Ultra-widefield fundus mosaic.
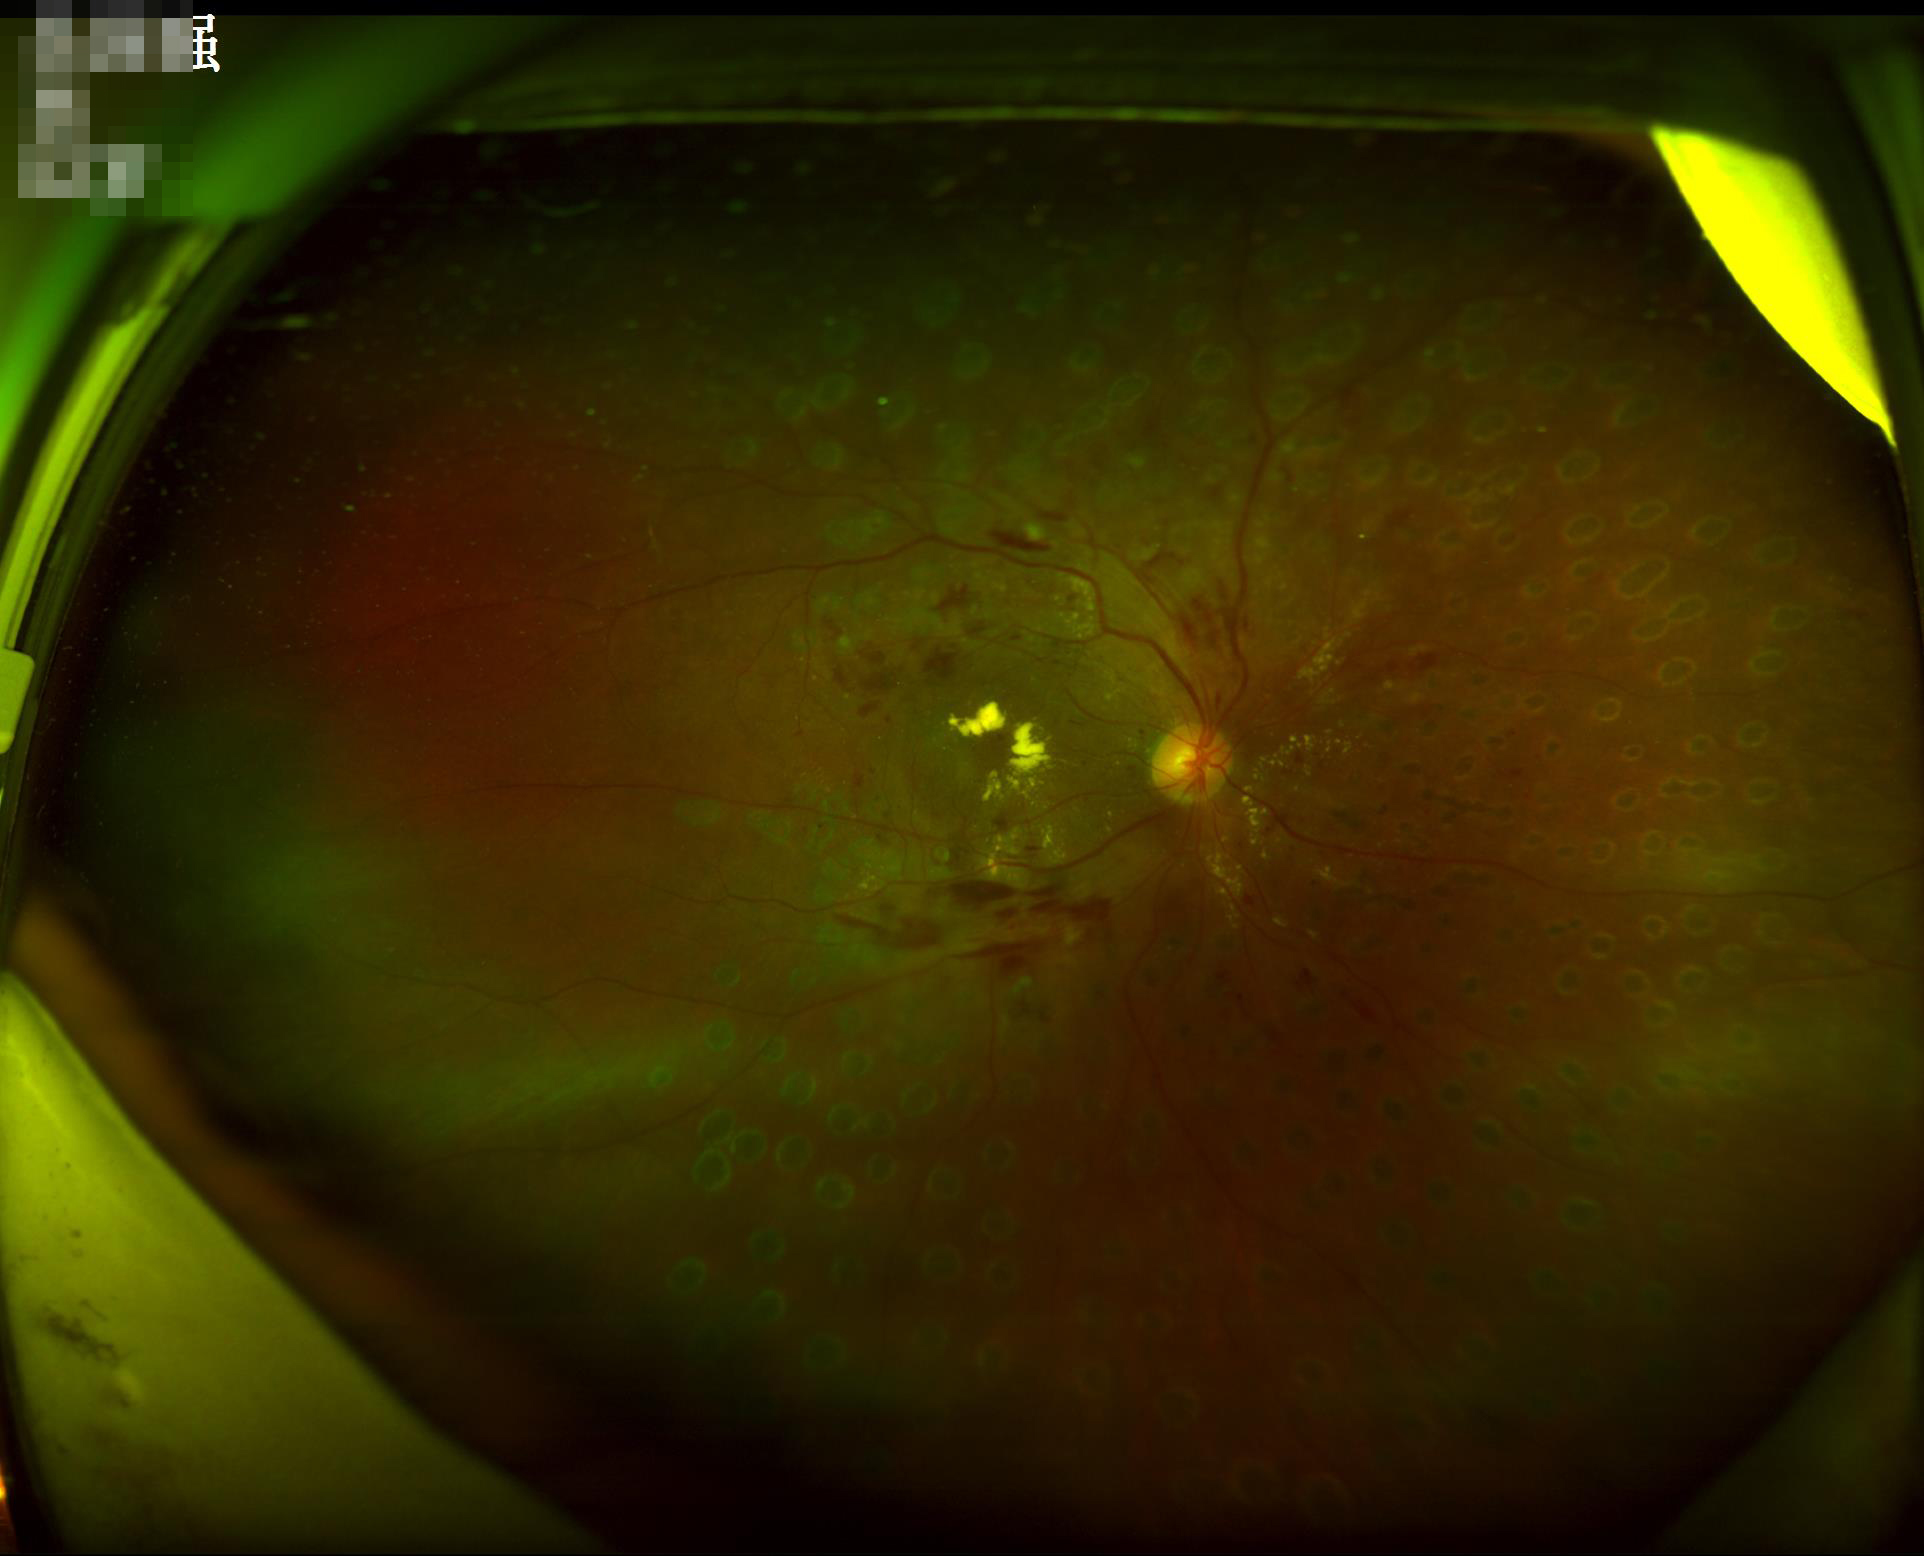

Poor illumination with uneven exposure. The image is blurry. Good dynamic range. Overall quality is poor; the image is difficult to grade.